Ultra-widefield fundus photograph:
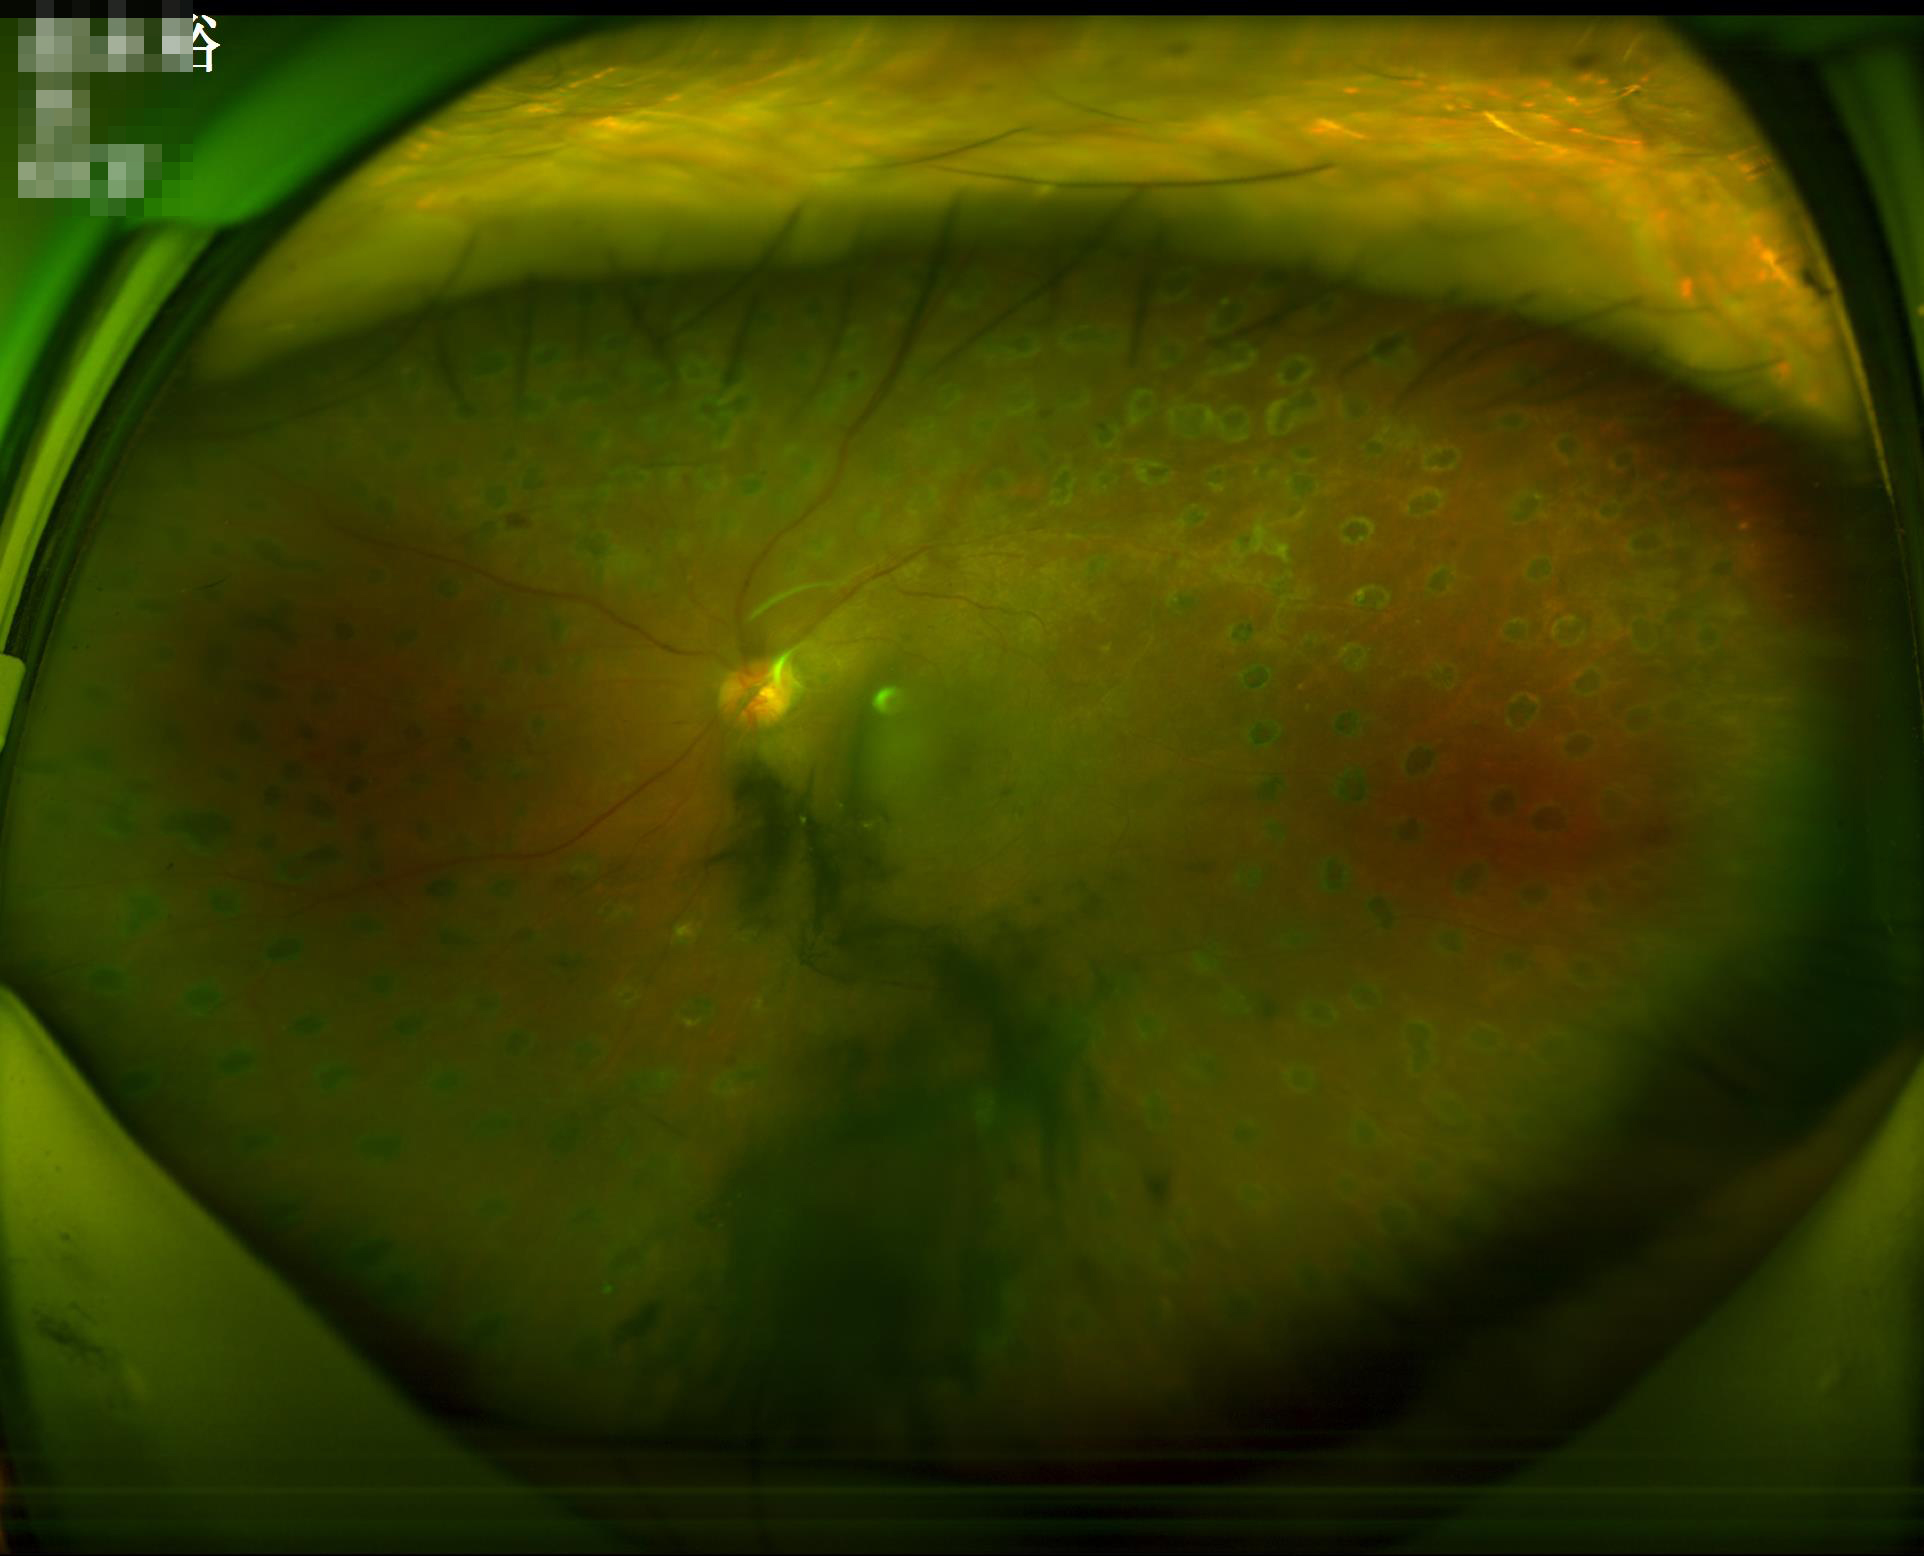

Overall quality = inadequate; Clarity = blurry; Illumination/color = suboptimal; Contrast = satisfactory.